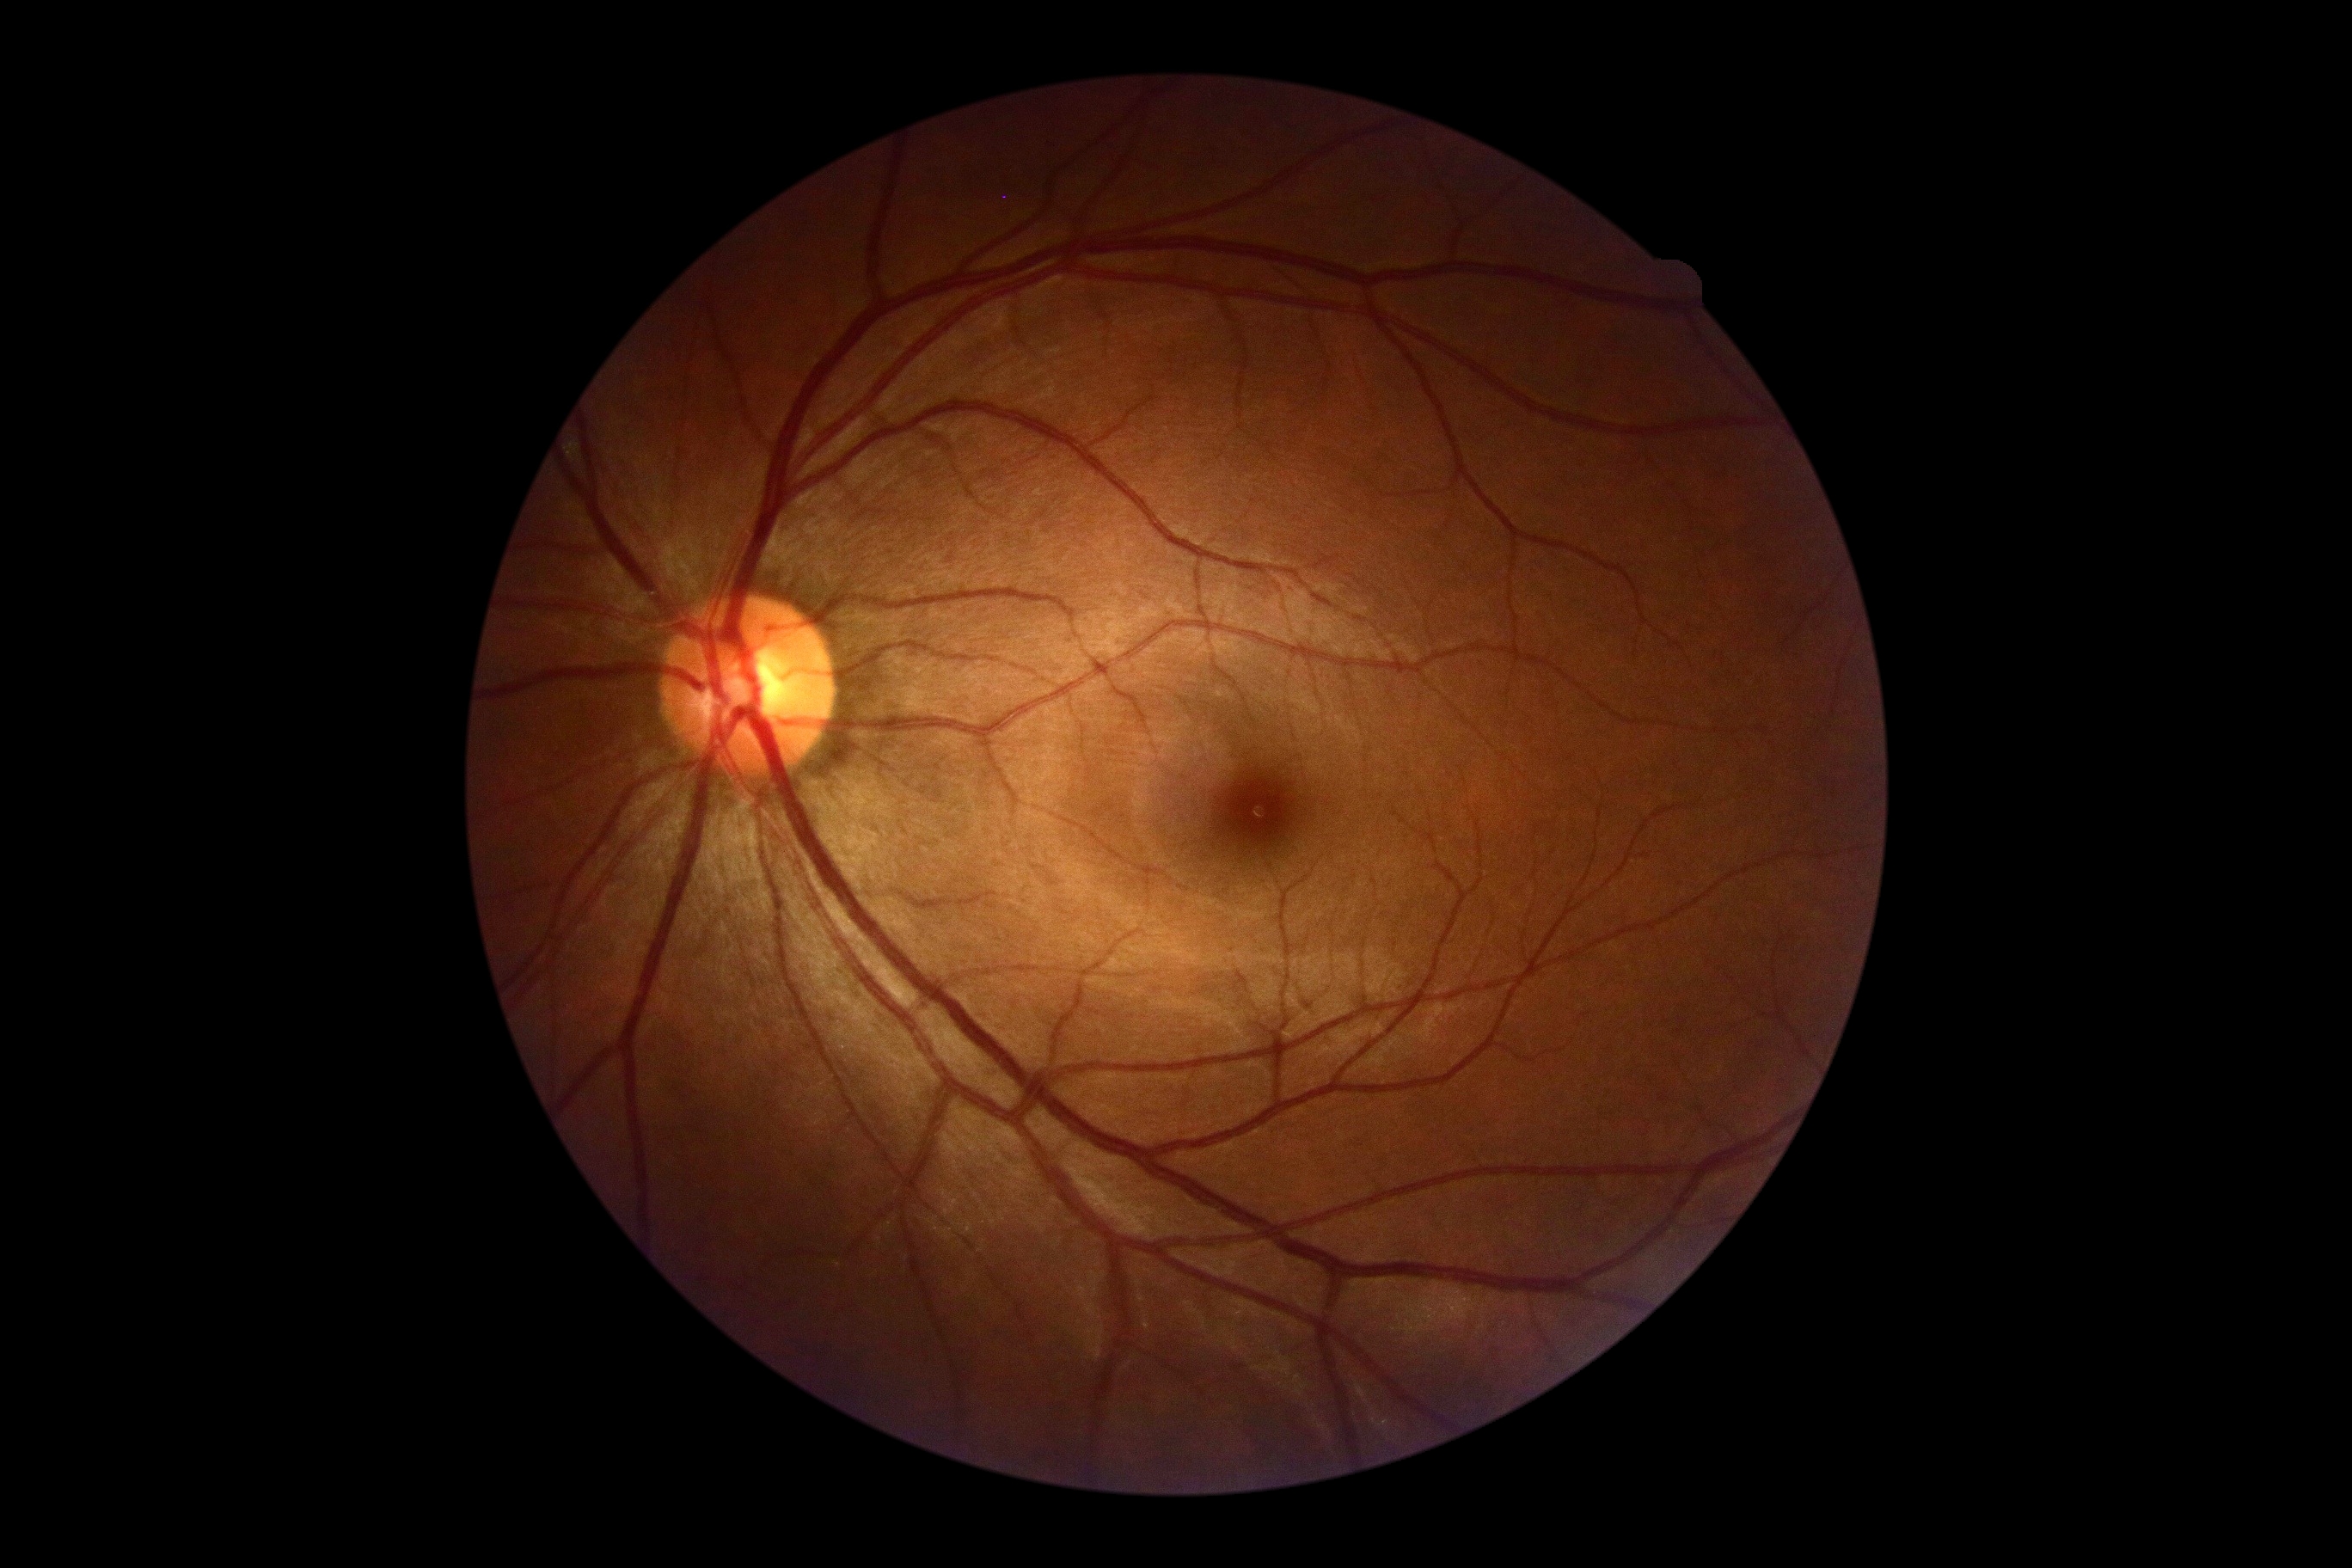 DR grade is 0 (no apparent retinopathy).